Posterior pole photograph · DR severity per modified Davis staging · no pharmacologic dilation — 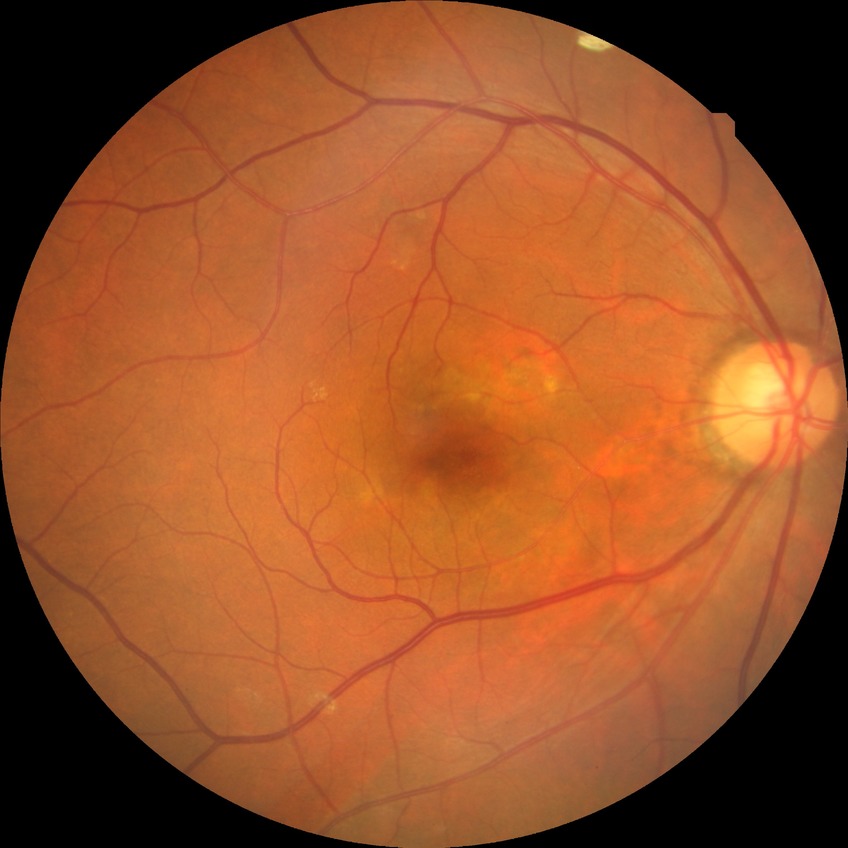 Diabetic retinopathy (DR): NDR (no diabetic retinopathy).